Modified Davis grading
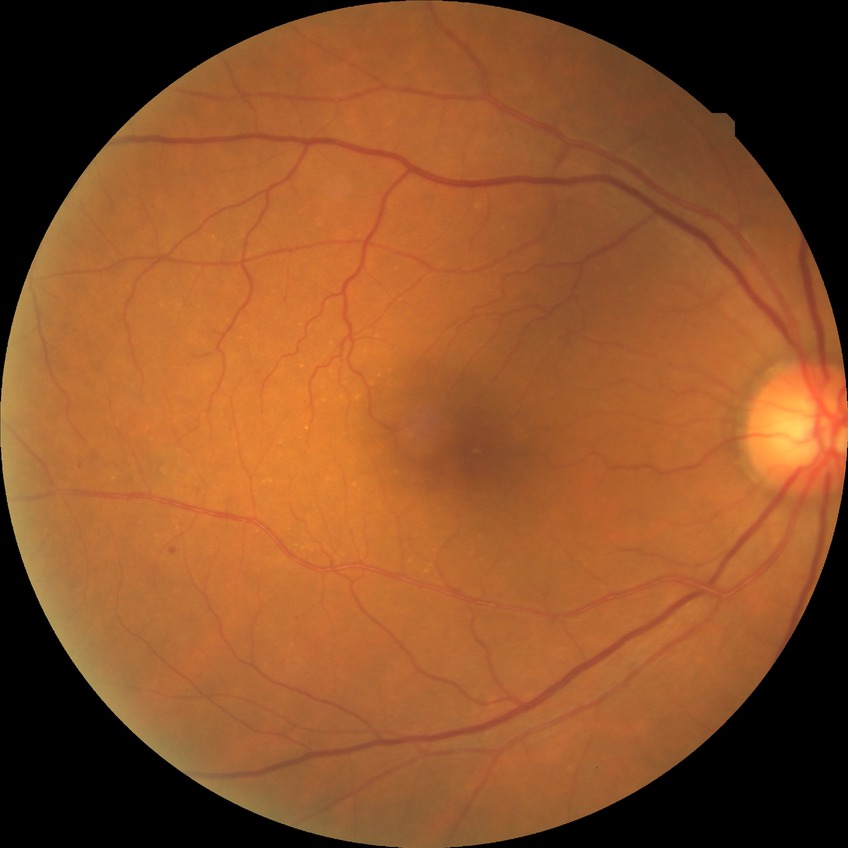 Modified Davis grading is no diabetic retinopathy.